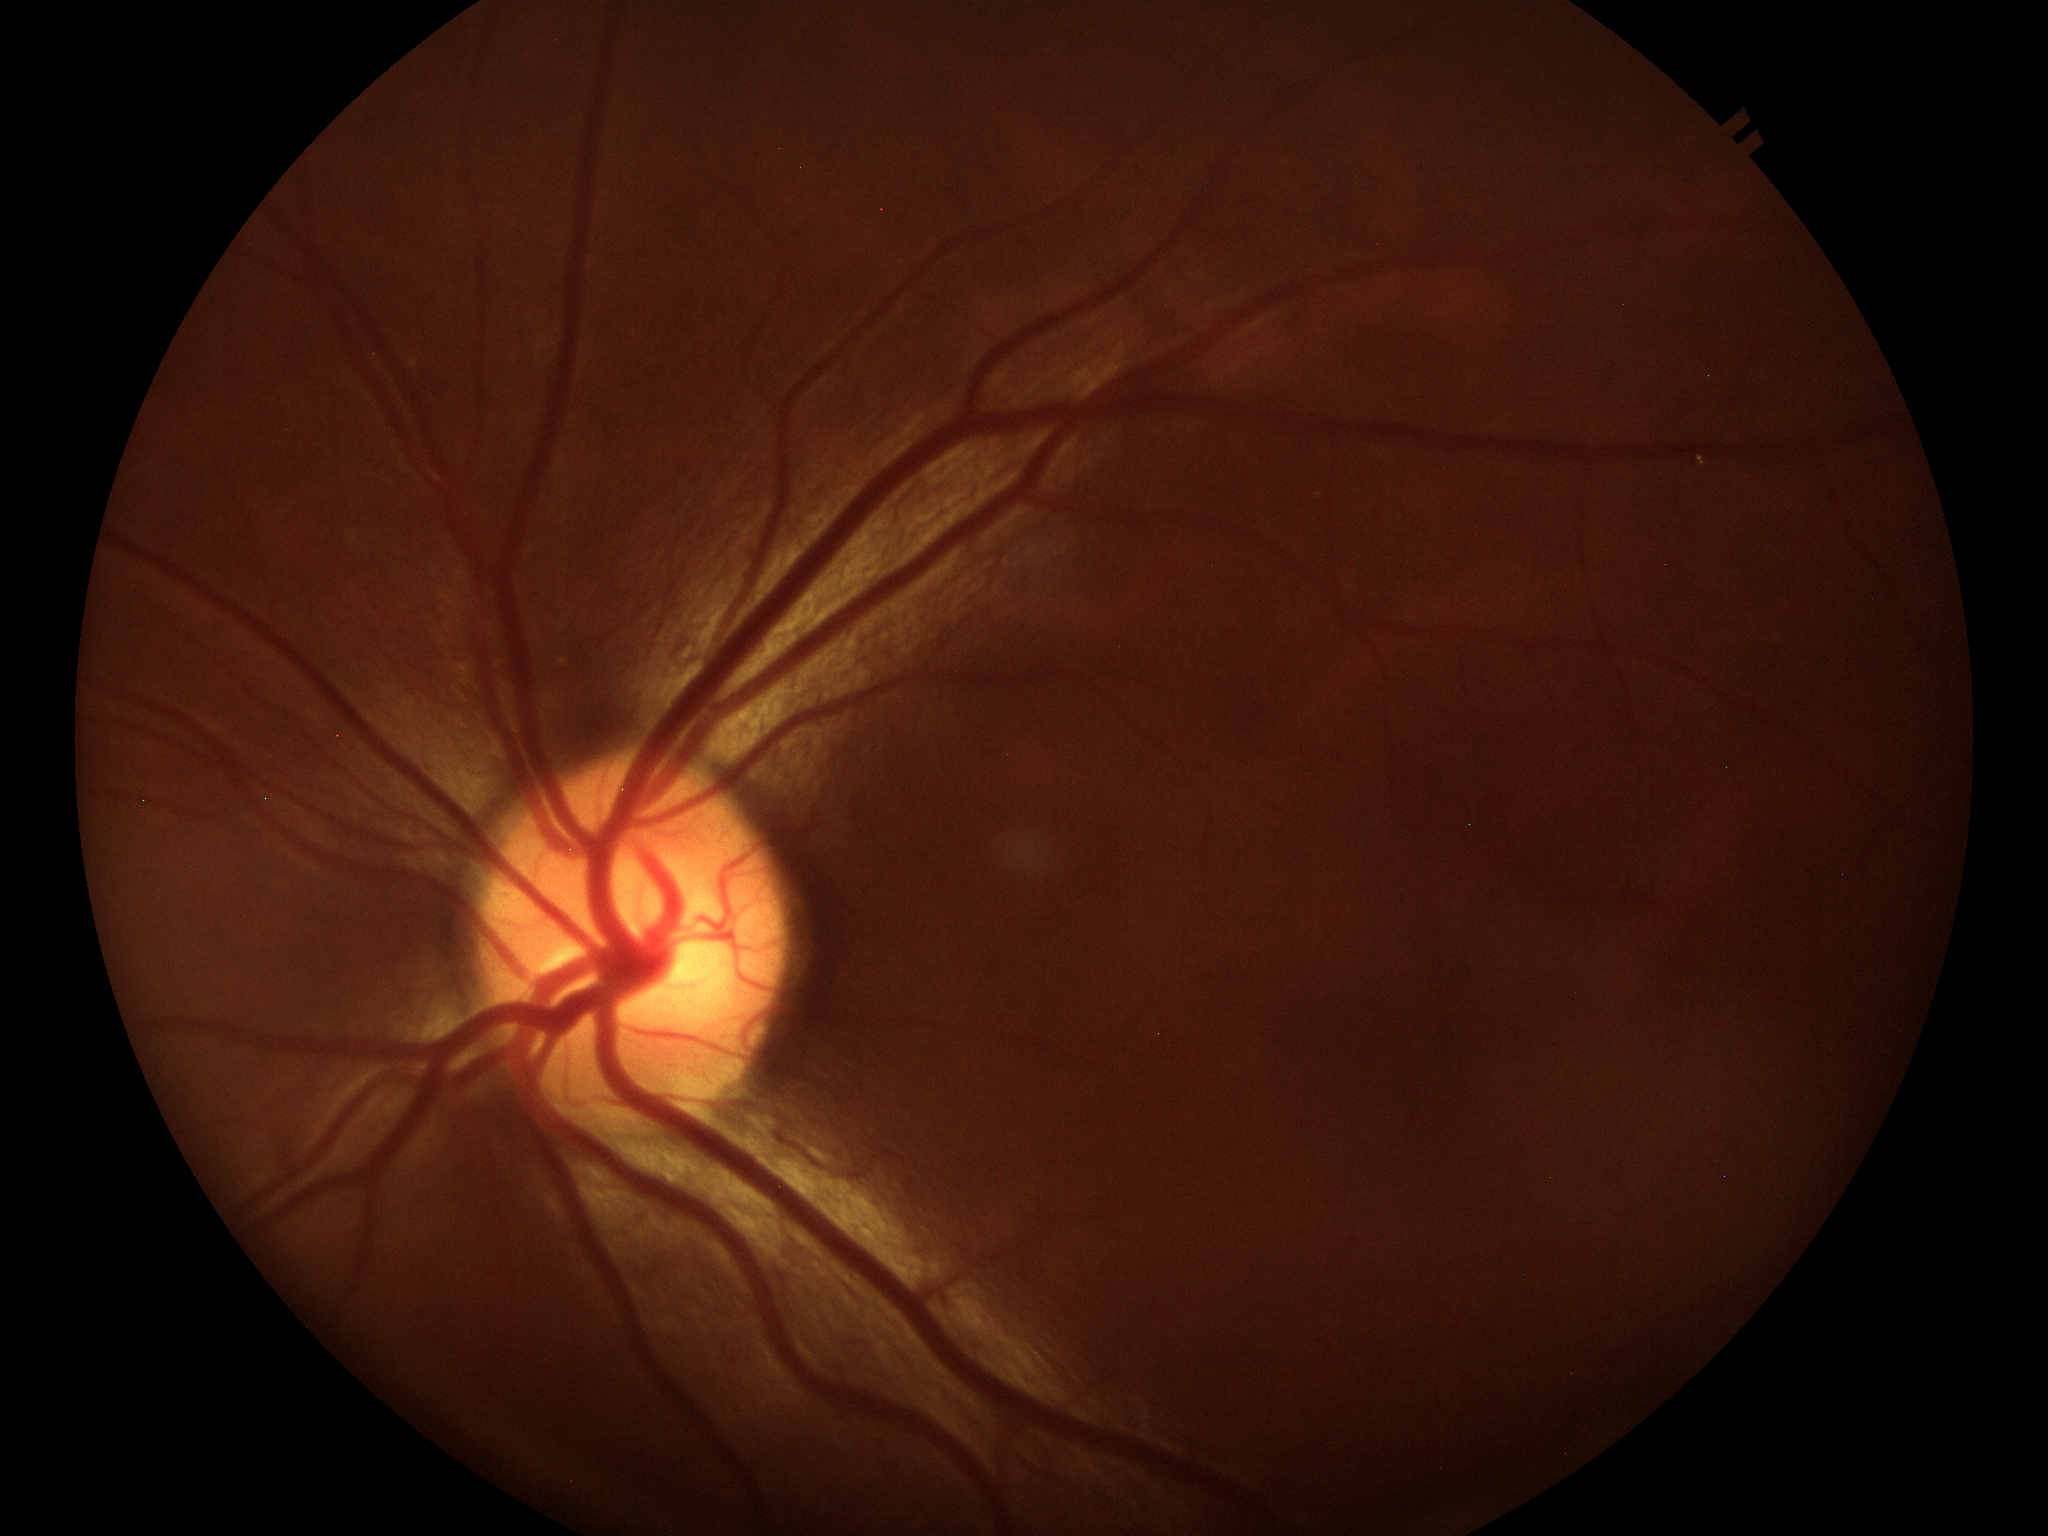
vertical cup-to-disc ratio (VCDR)=0.49
Glaucoma screening impression=not suspect